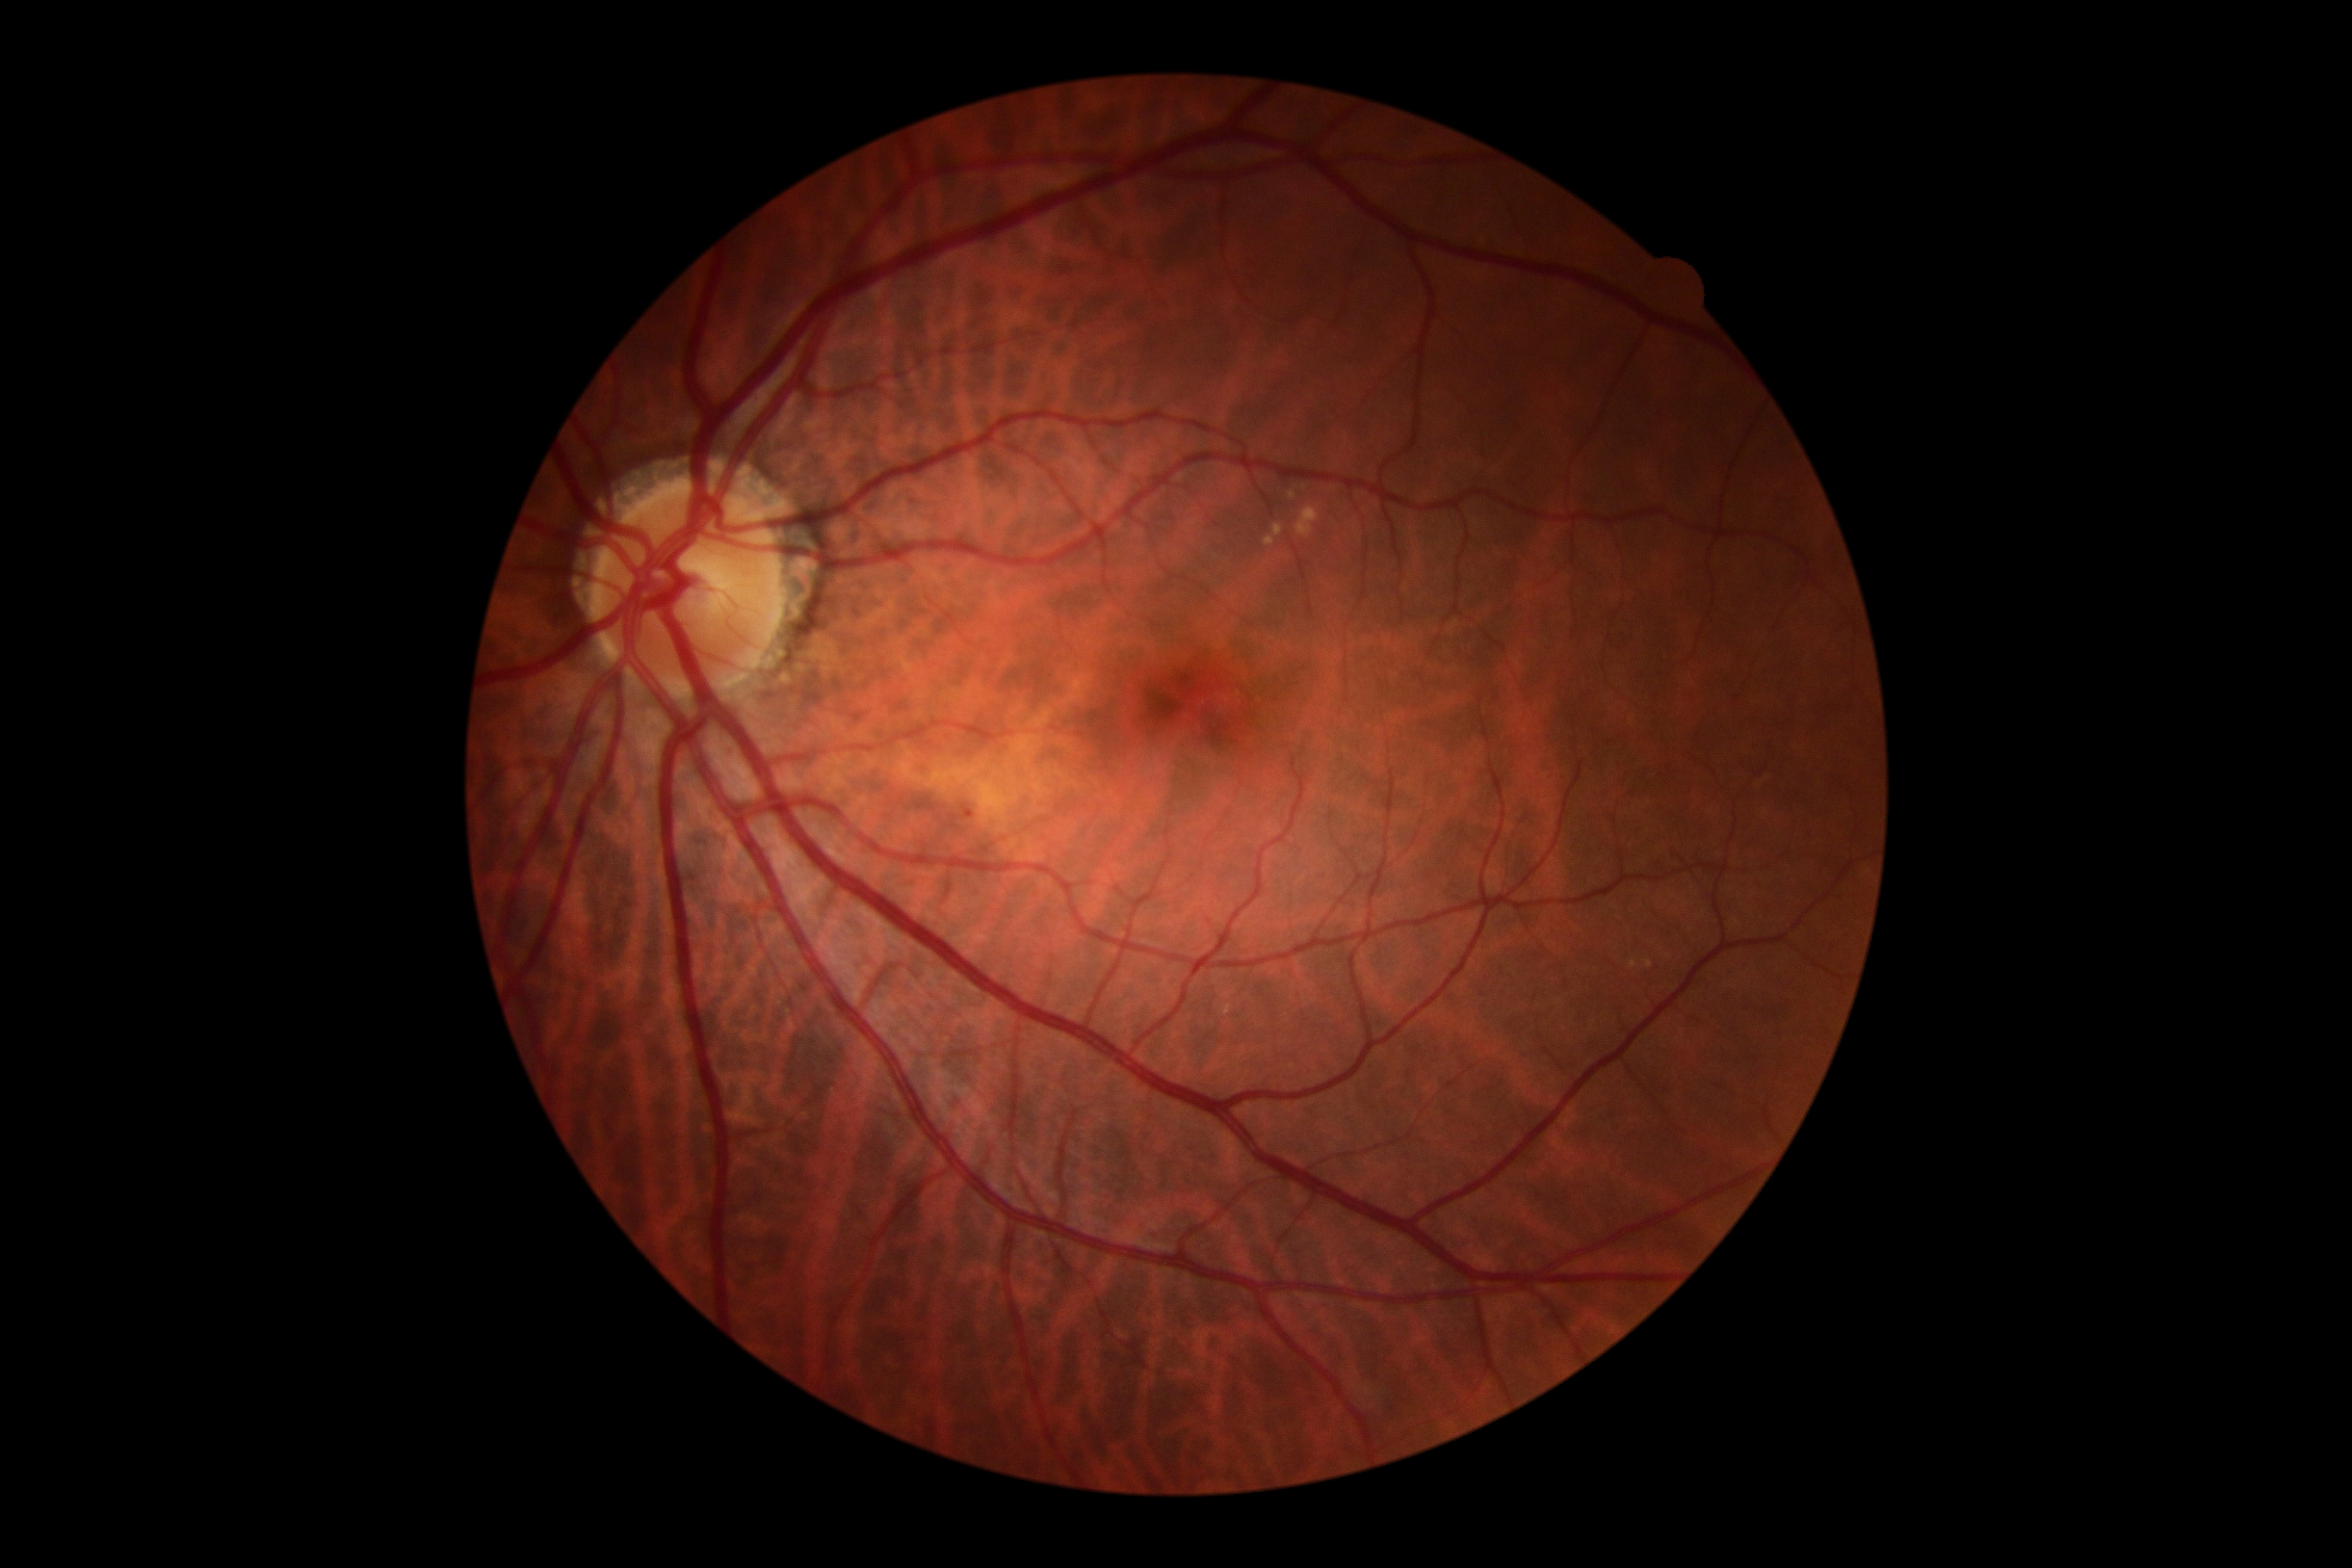 Diabetic retinopathy grade is mild non-proliferative diabetic retinopathy (1).